Without pupil dilation · FOV: 45 degrees
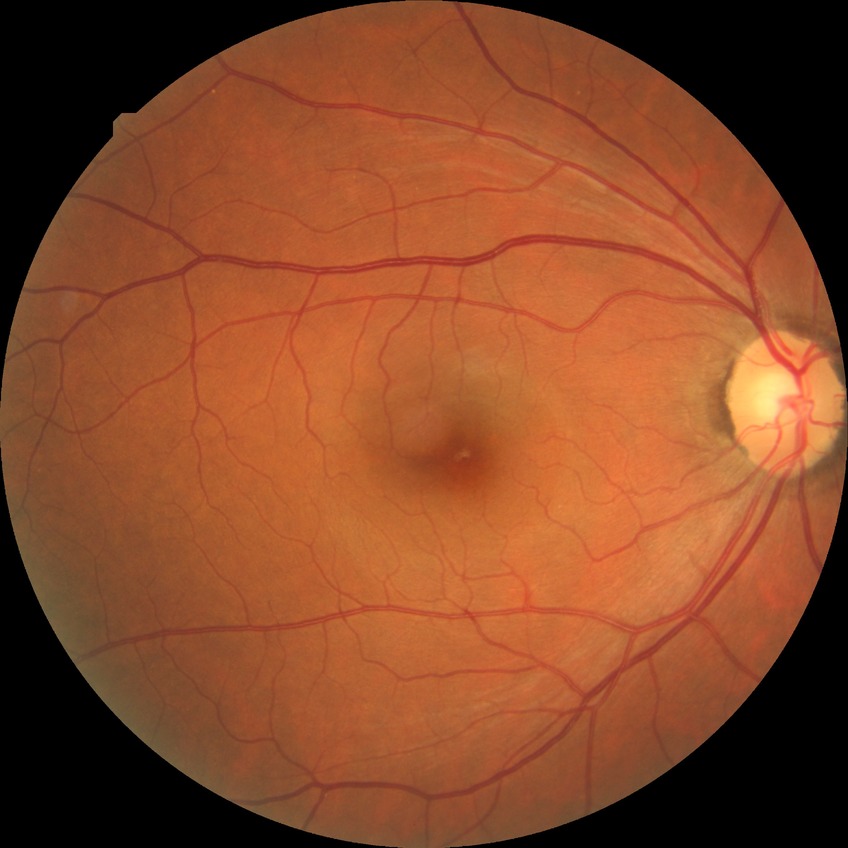 diabetic retinopathy (DR): NDR (no diabetic retinopathy)